Image size 1440x1080. Pediatric wide-field fundus photograph:
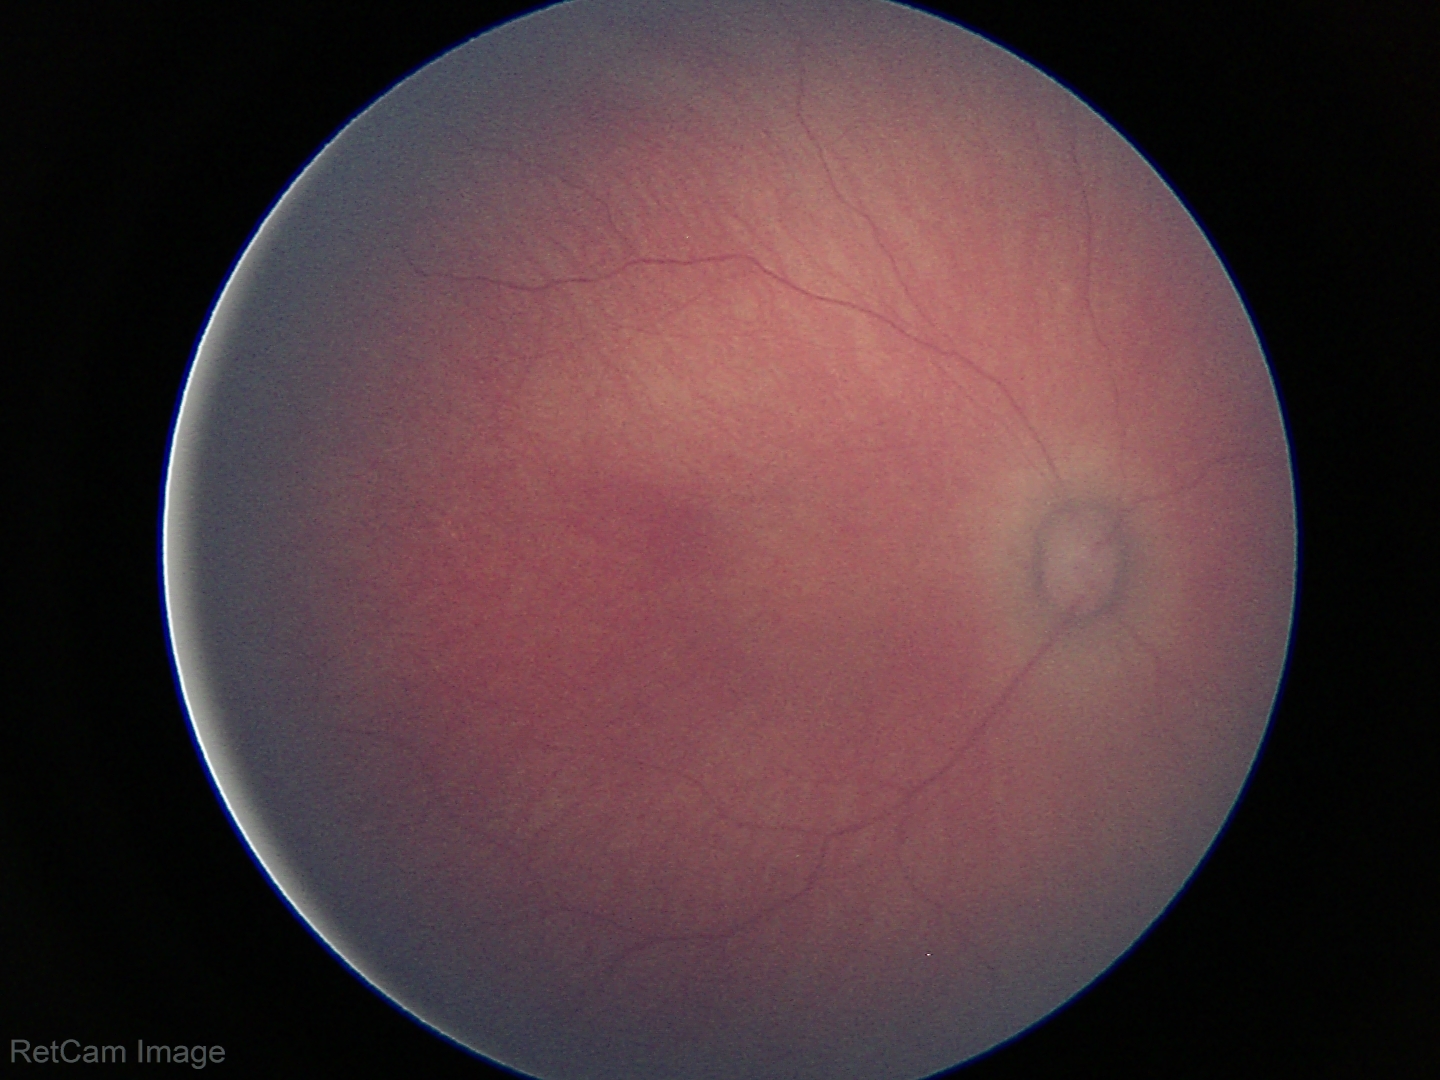 Impression: normal retinal appearance.